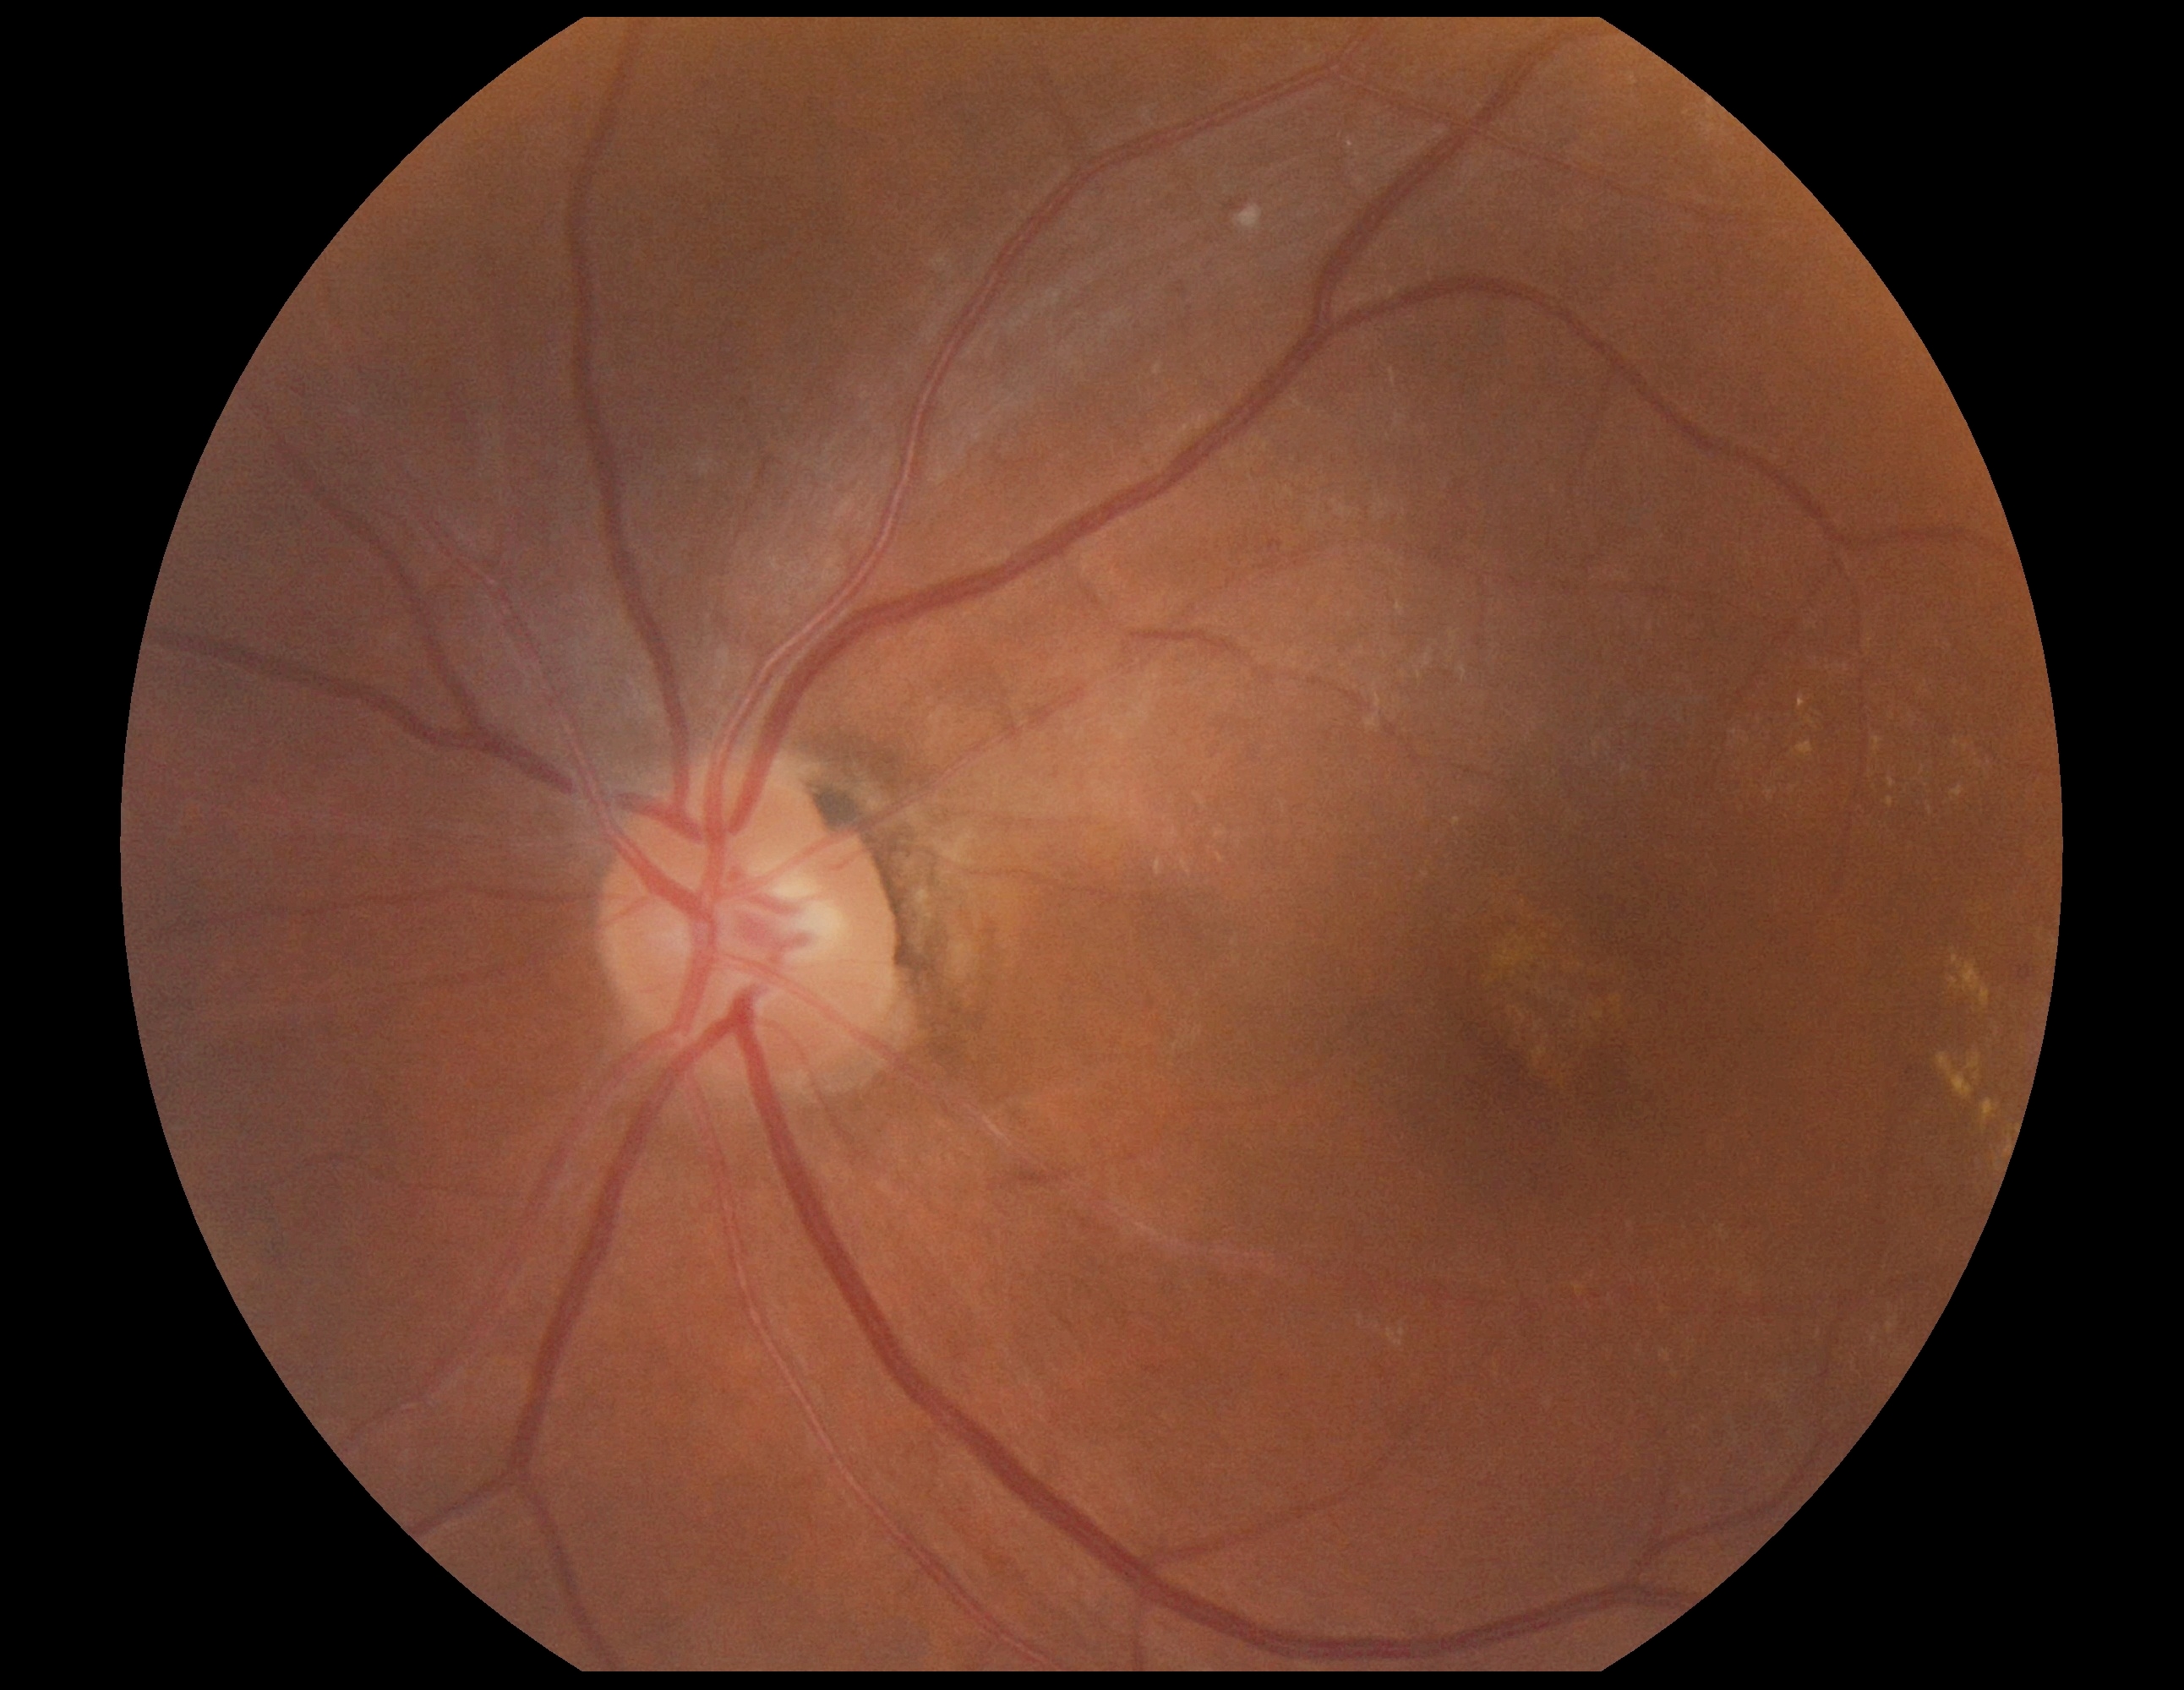 DR severity=grade 2 (moderate NPDR); DR class=non-proliferative diabetic retinopathy.